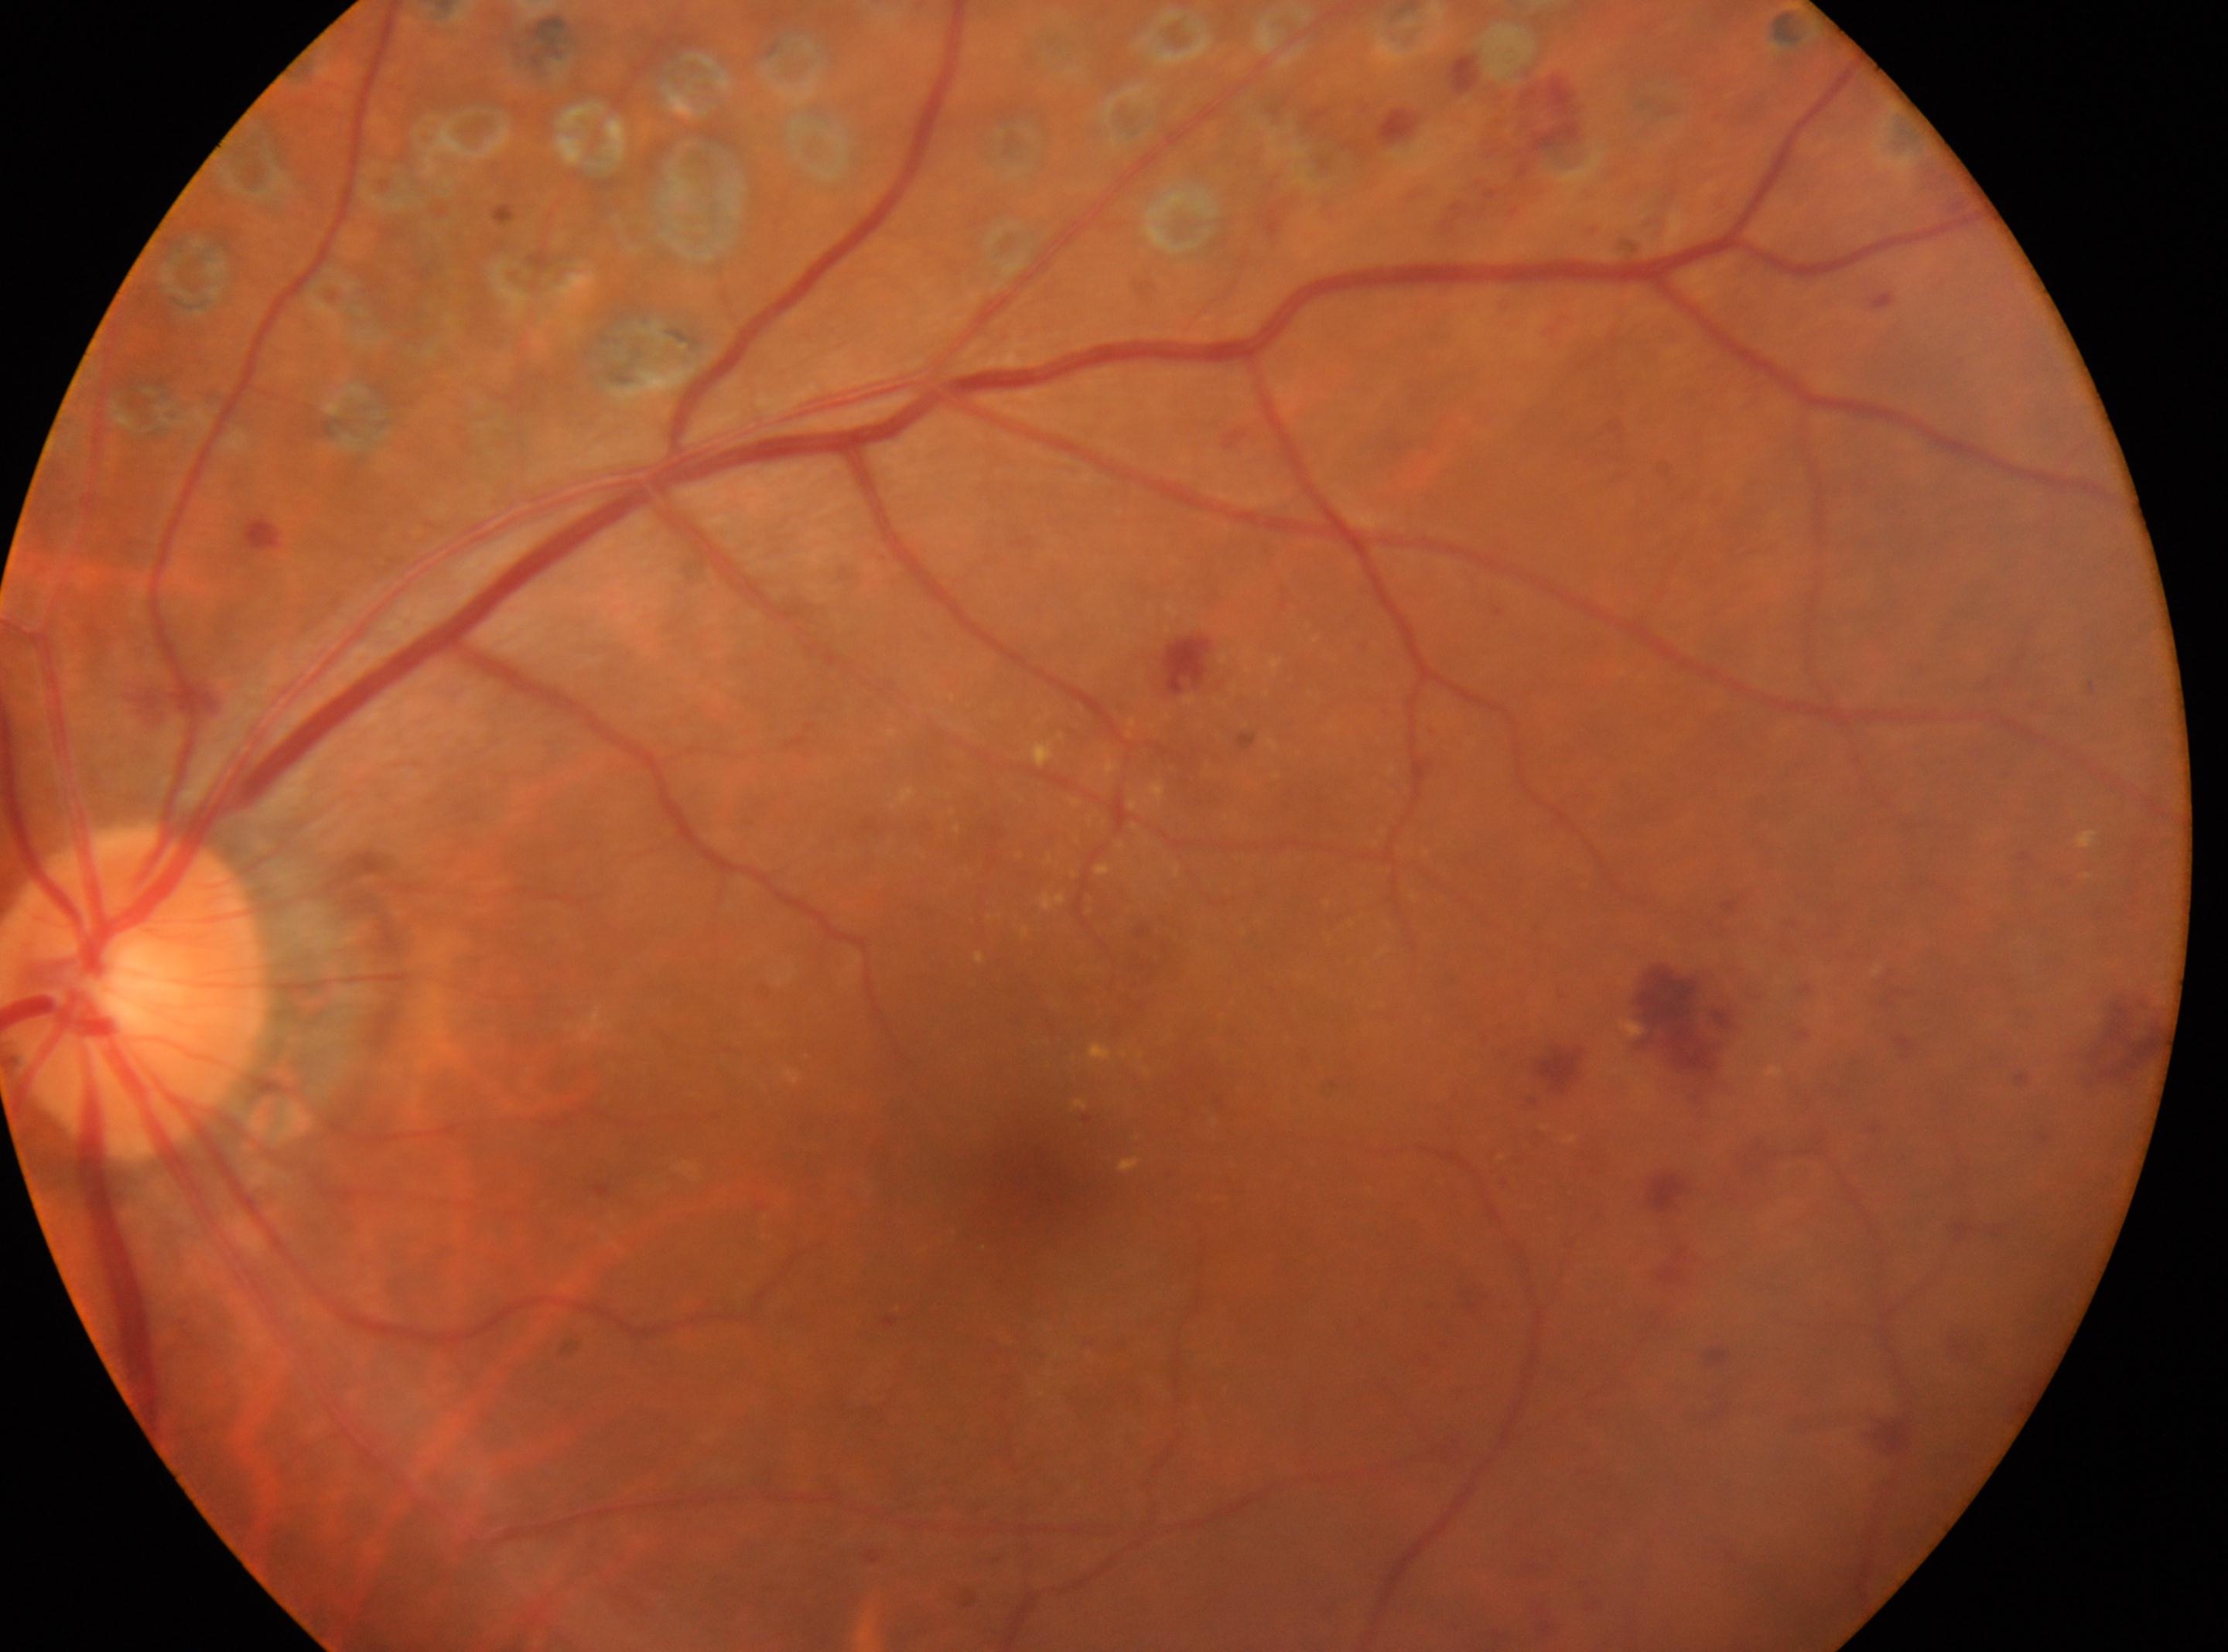
| feature | annotation |
|---|---|
| laterality | left |
| DR severity | DR with laser spots or scars, underlying severity moderate NPDR (grade 2) |
| fovea center | x=1030, y=1183 |
| the optic disc | x=136, y=993 |